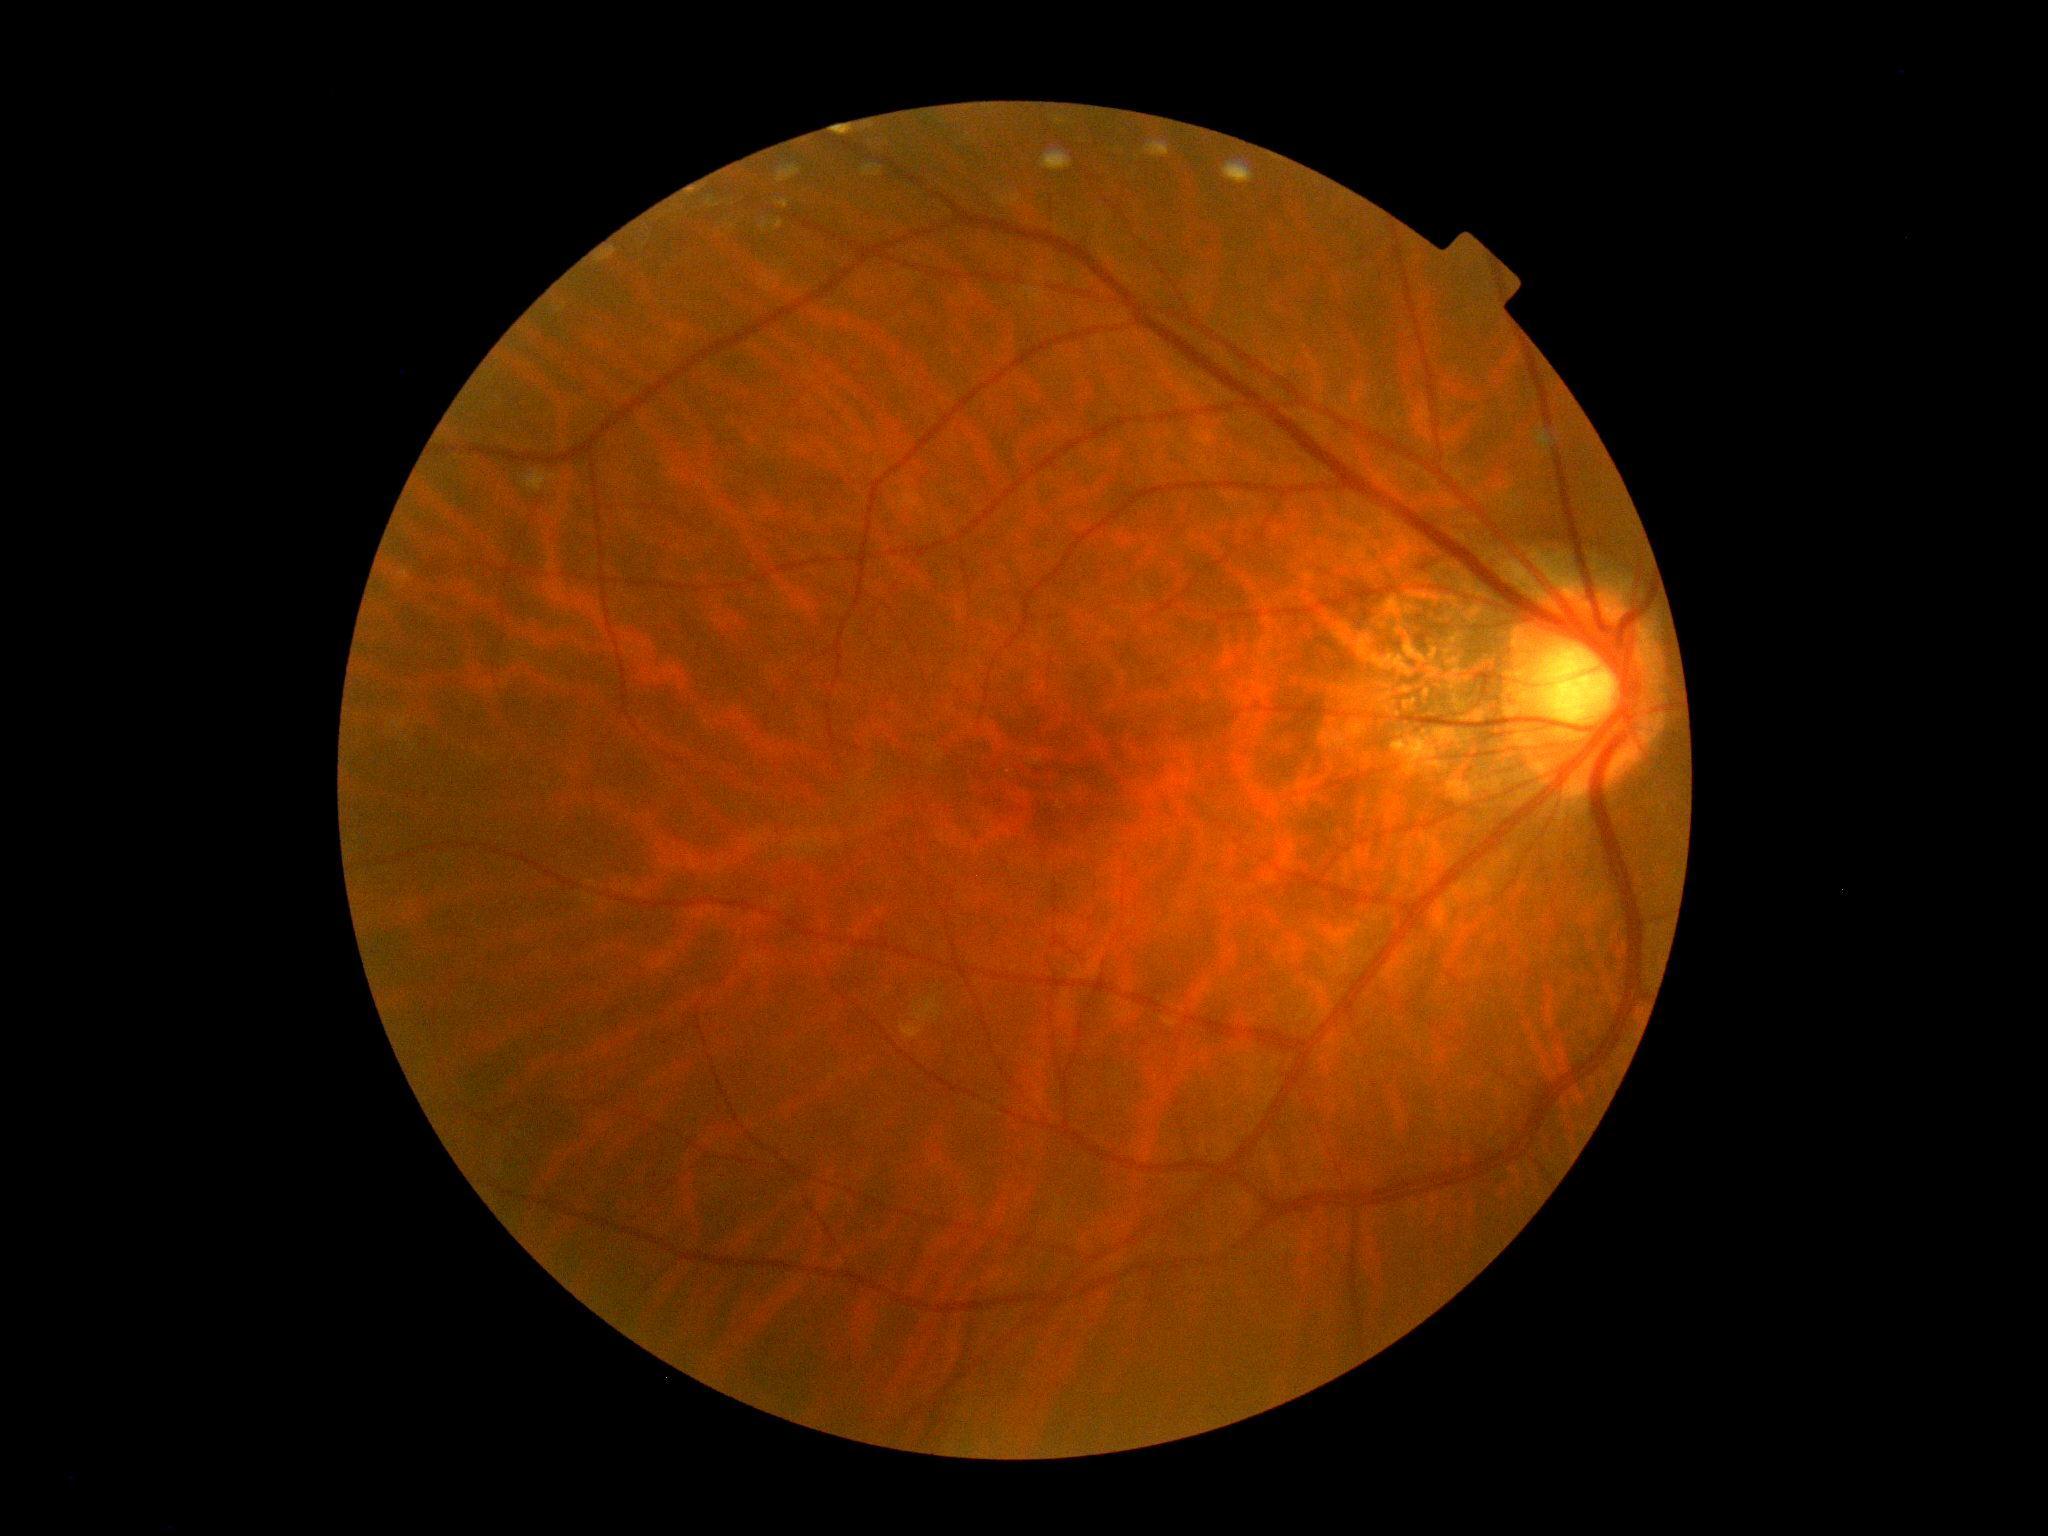 * DR — 0